FOV: 45 degrees.
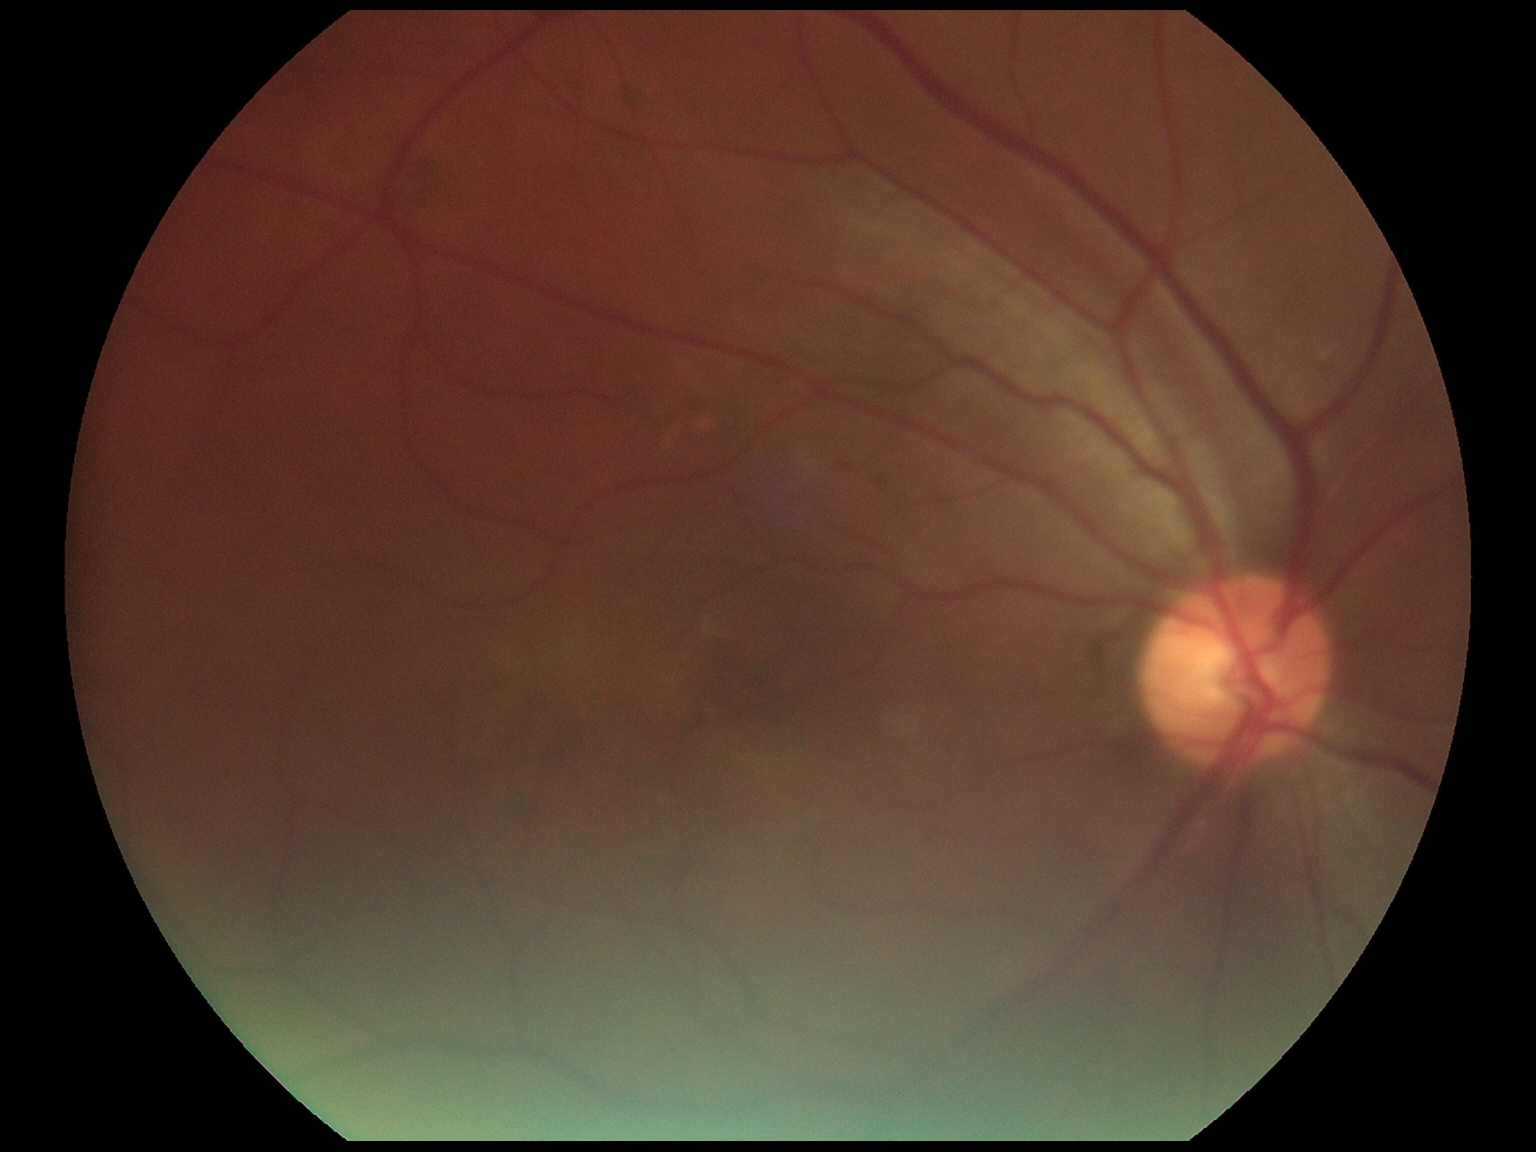
DR stage is grade 1 (mild NPDR).